Ultra-widefield fundus photograph: 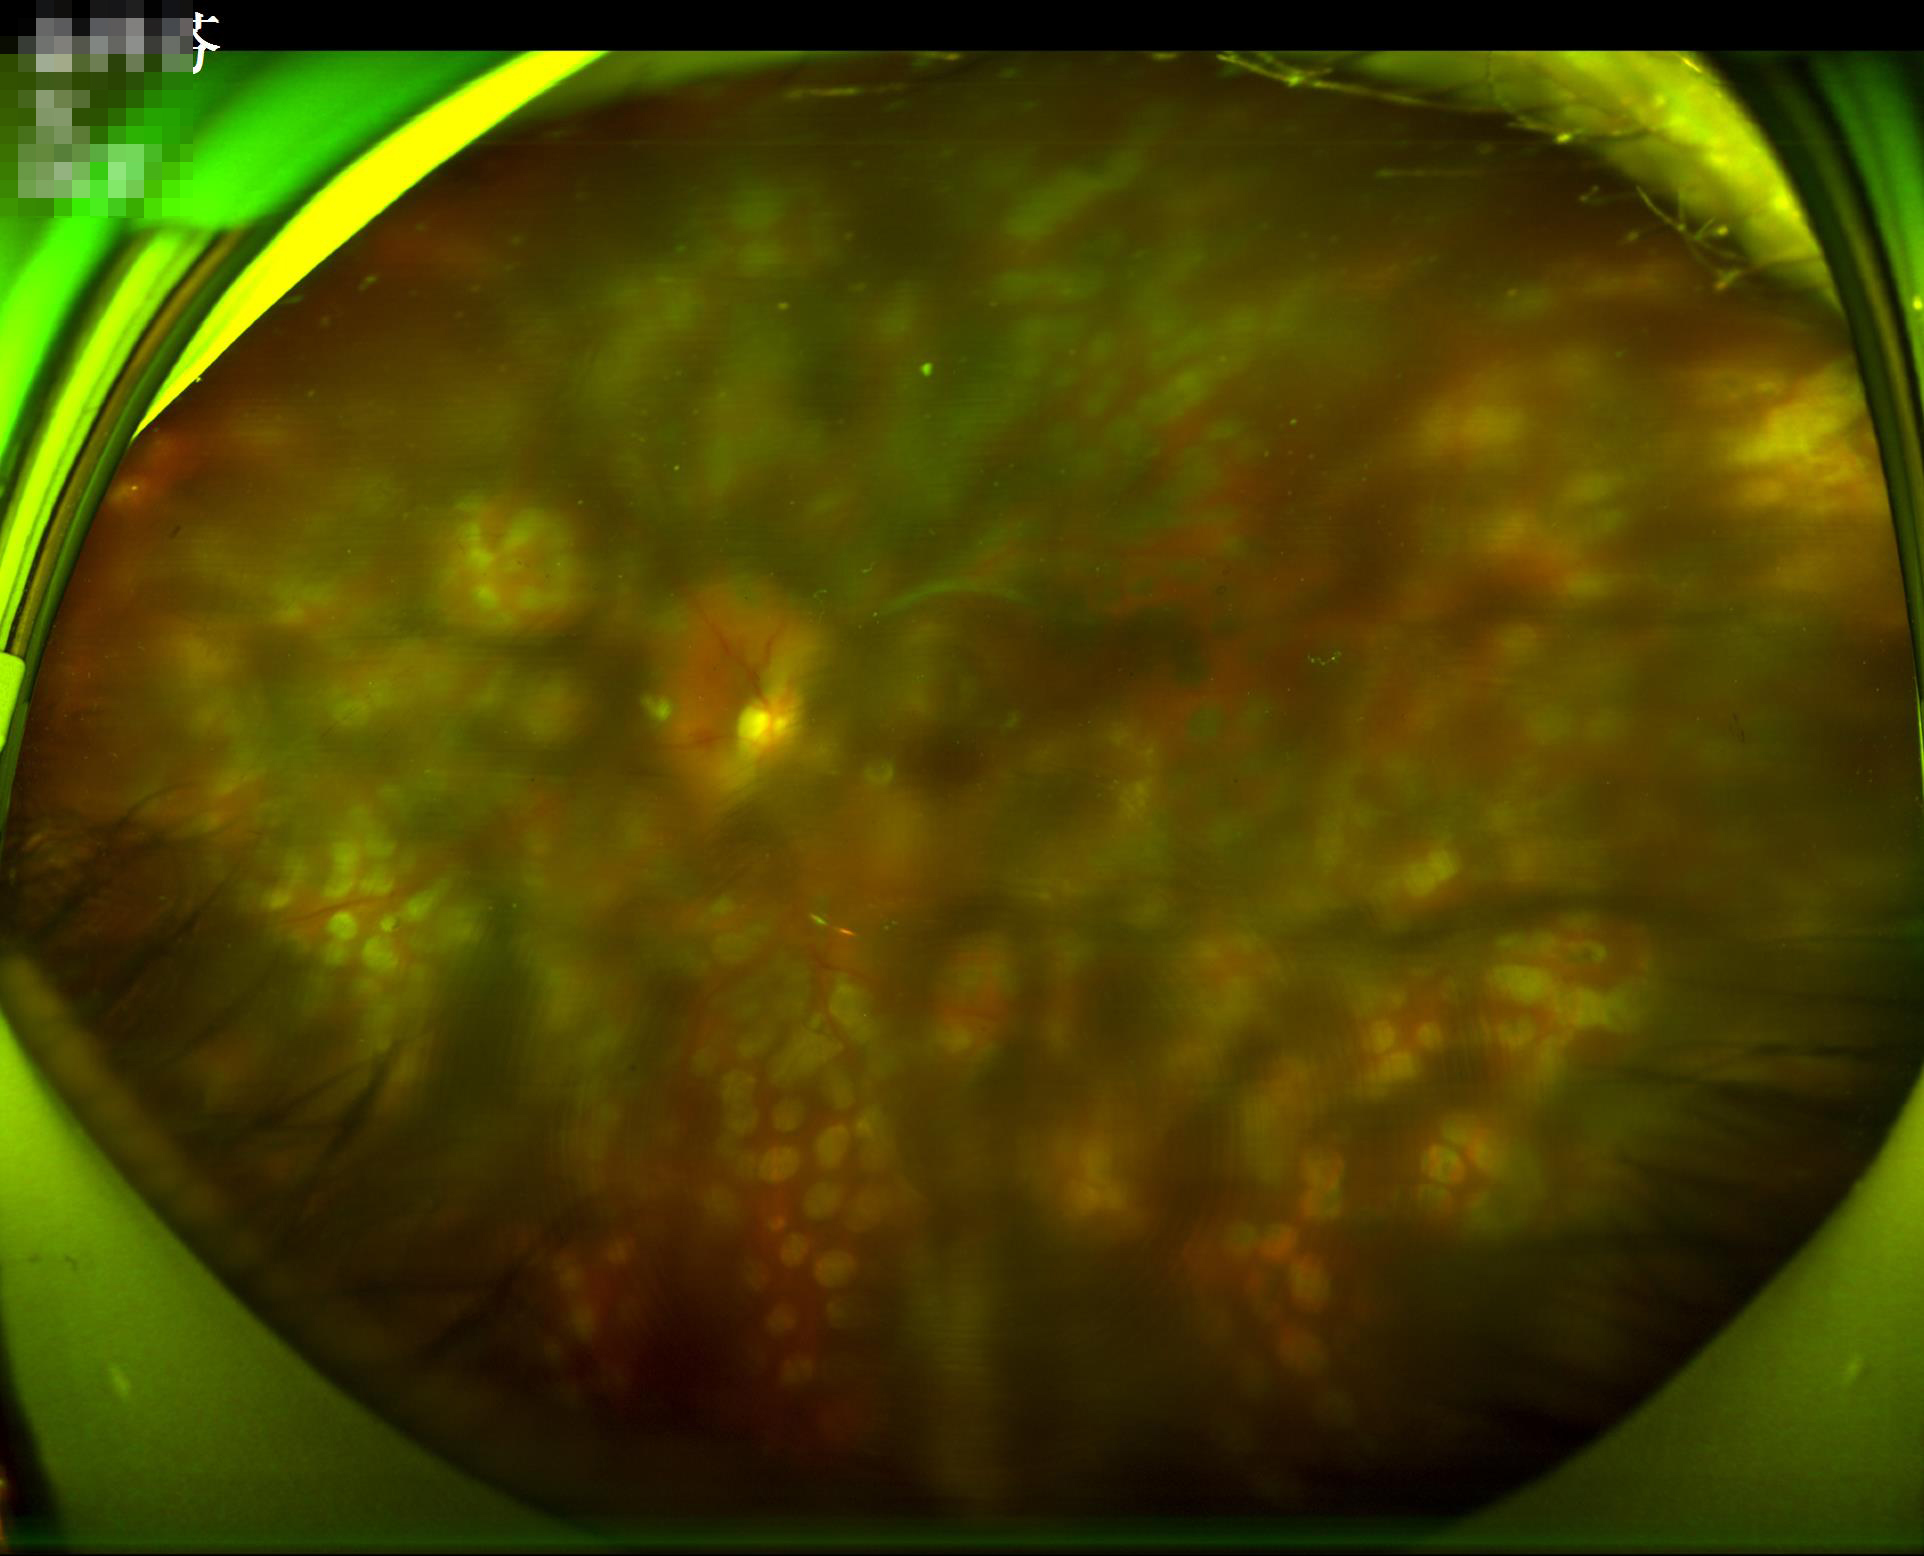

Illumination = over- or under-exposed | Sharpness = reduced sharpness with visible blur | Contrast = low, vessels and details hard to distinguish | Overall image quality = poor, ungradable.